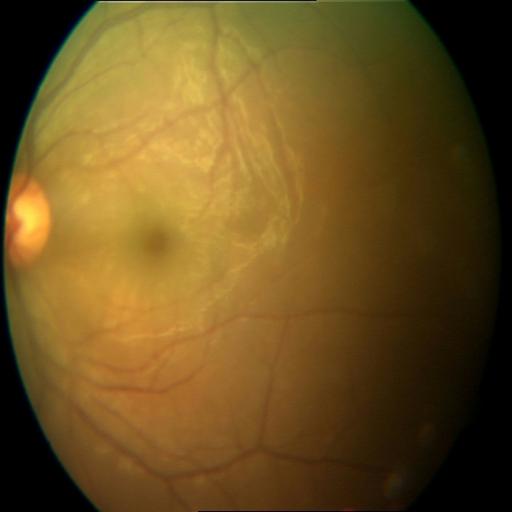 Pathology: cystoid macular edema.